Camera: NIDEK AFC-230
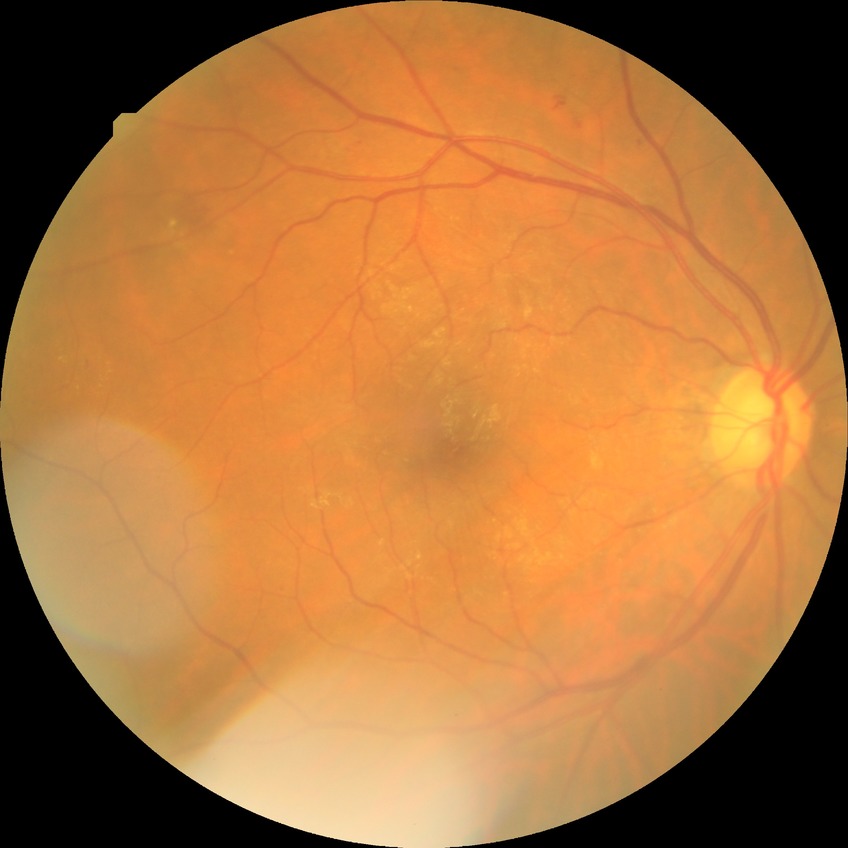 {
  "davis_grade": "simple diabetic retinopathy"
}